Diabetic retinopathy graded by the modified Davis classification
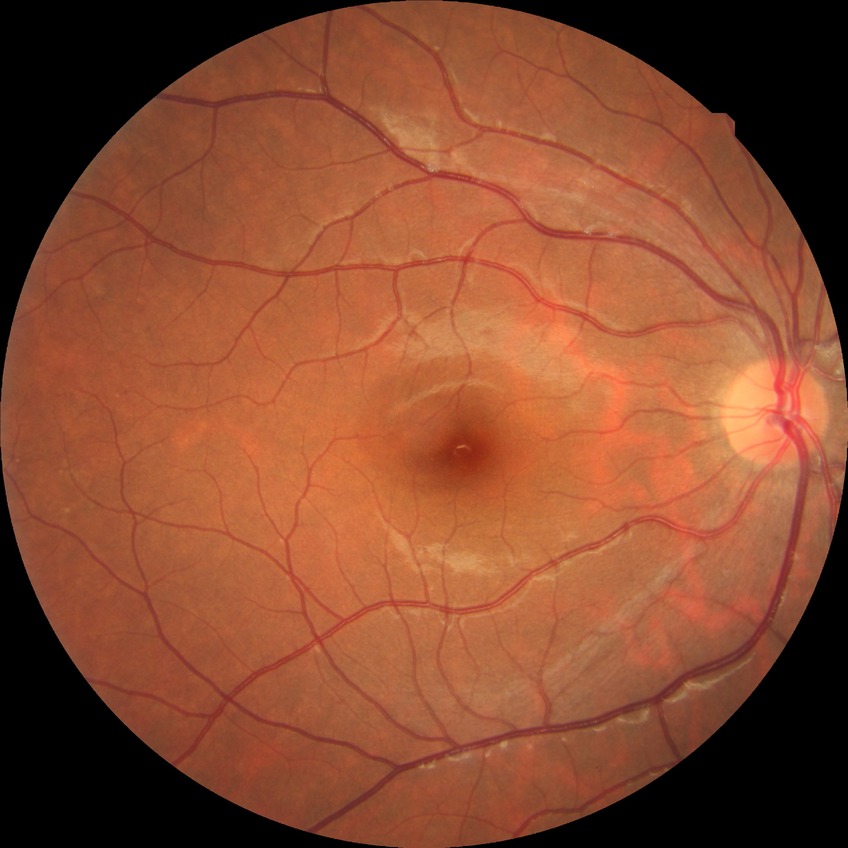 davis_grade: NDR
dr_impression: no signs of DR